FOV: 45 degrees; color fundus photograph
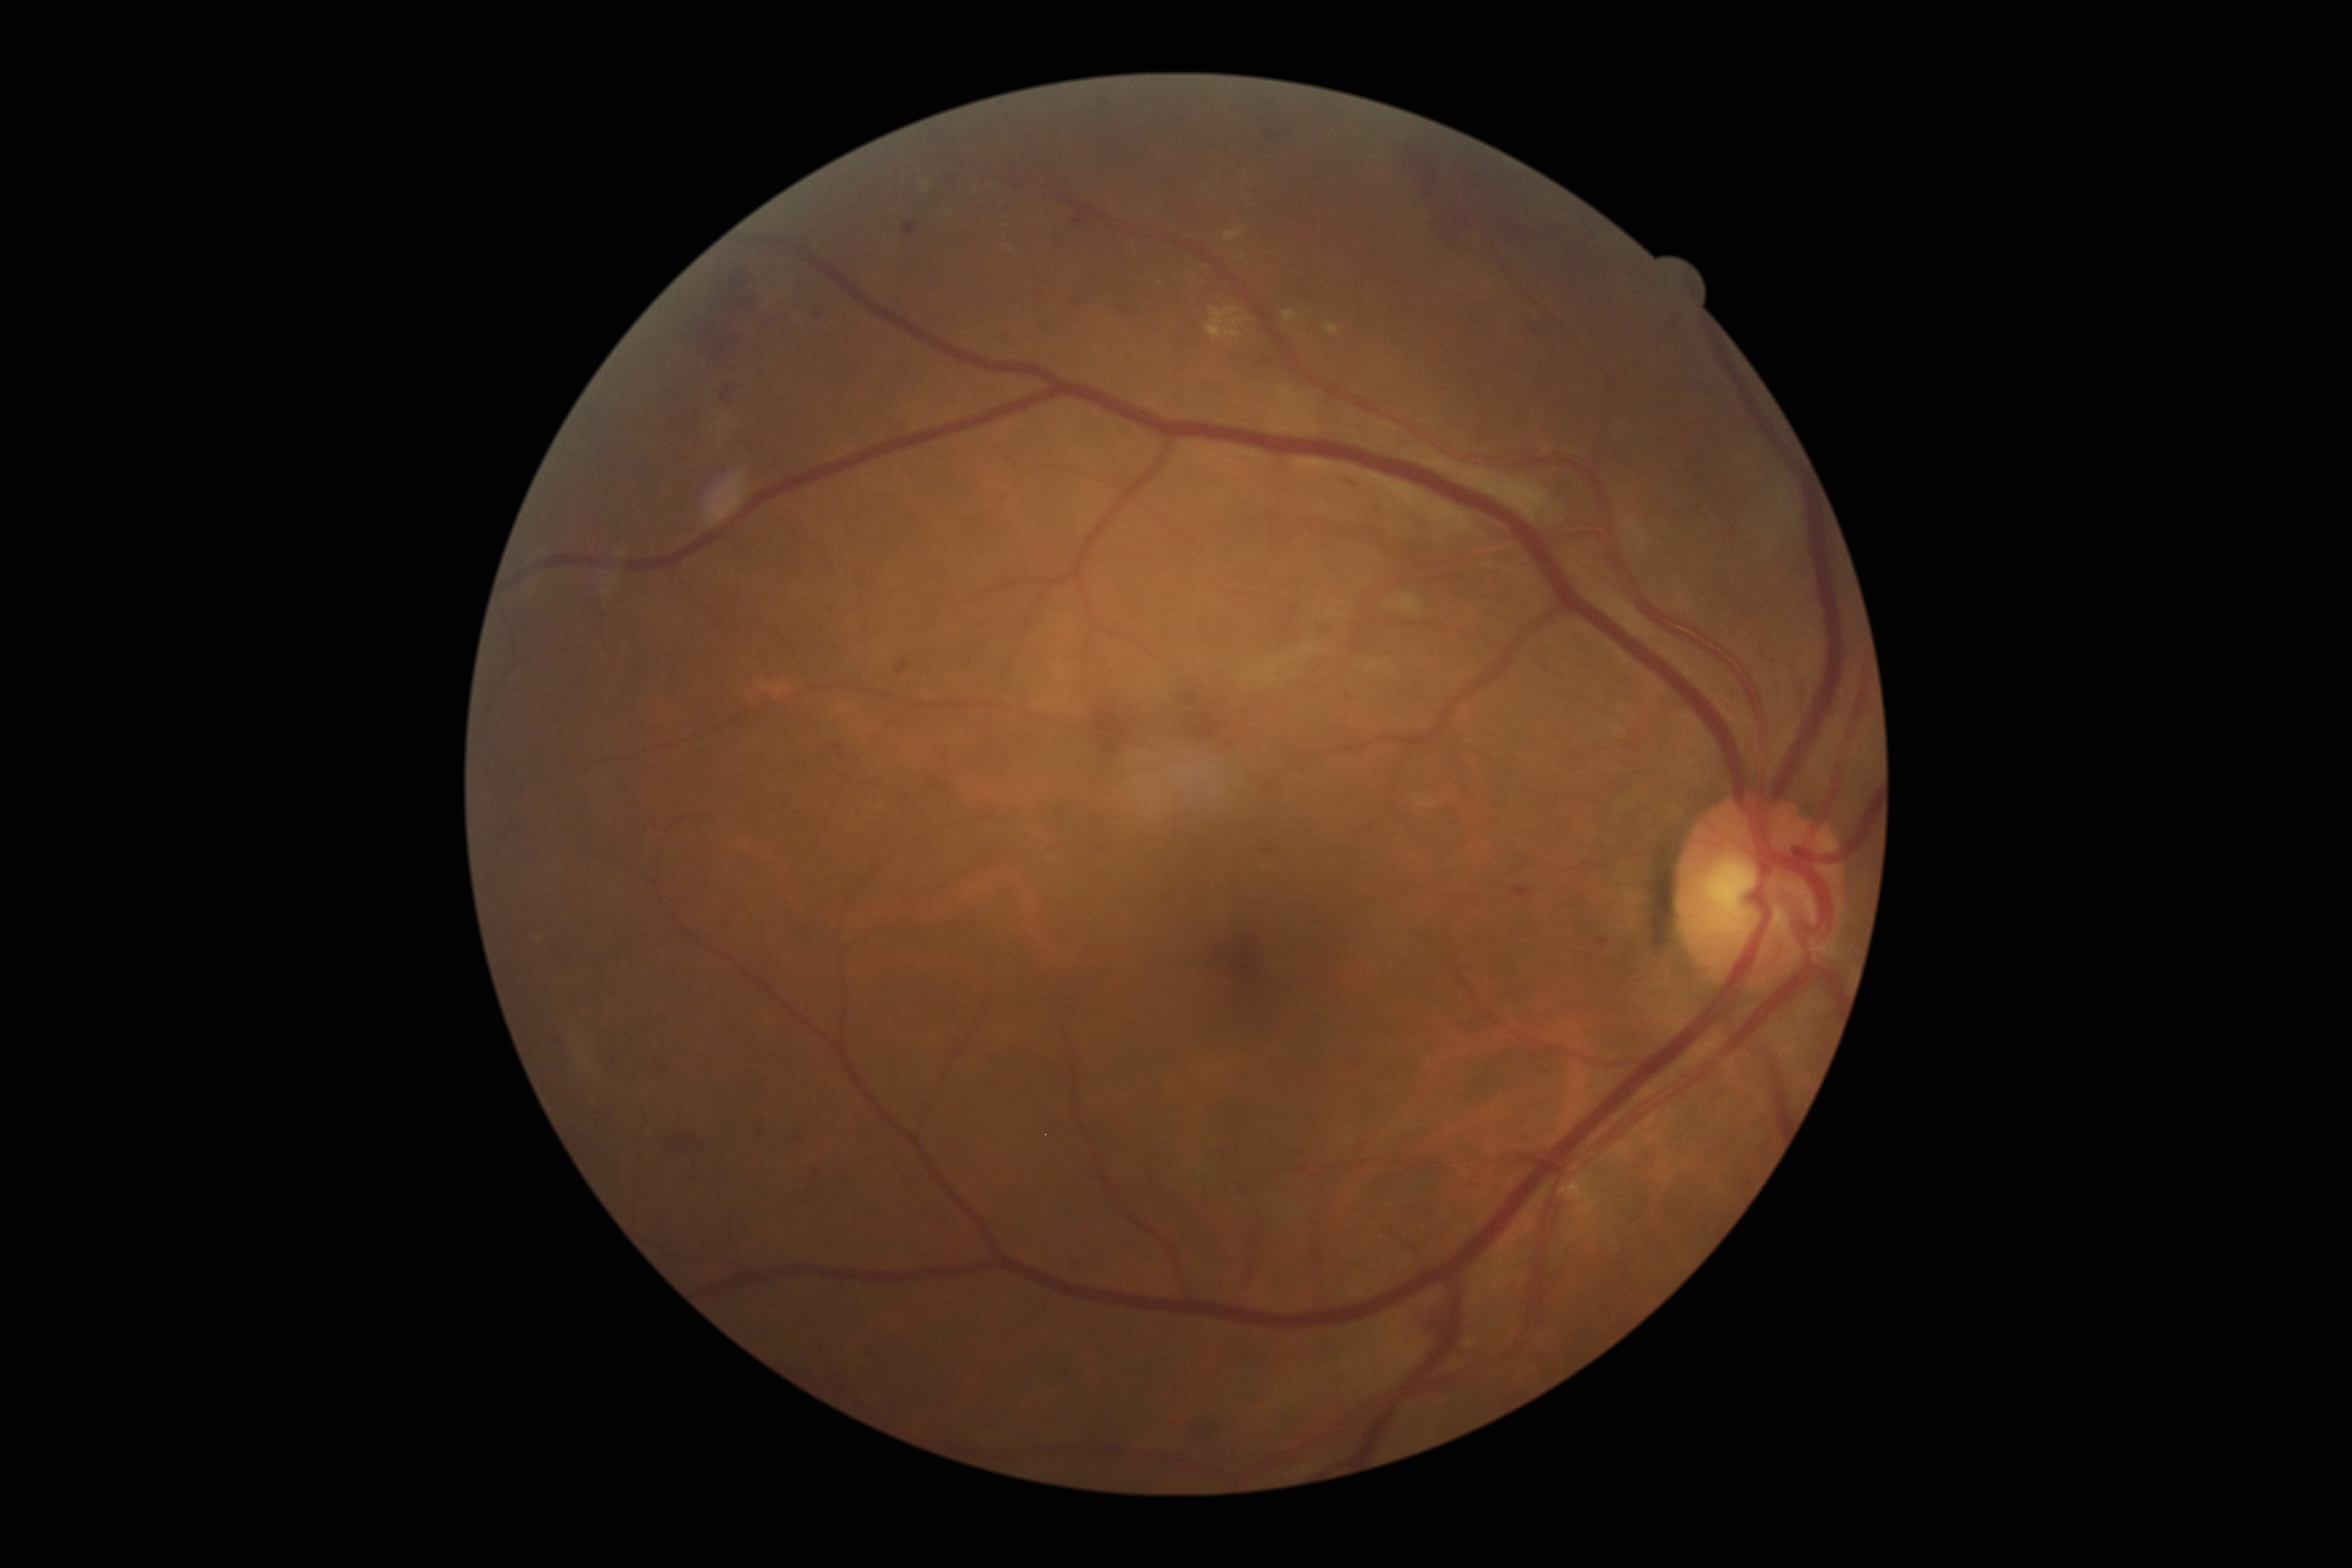

DR class: non-proliferative diabetic retinopathy.
DR: grade 2 (moderate NPDR) — more than just microaneurysms but less than severe NPDR.